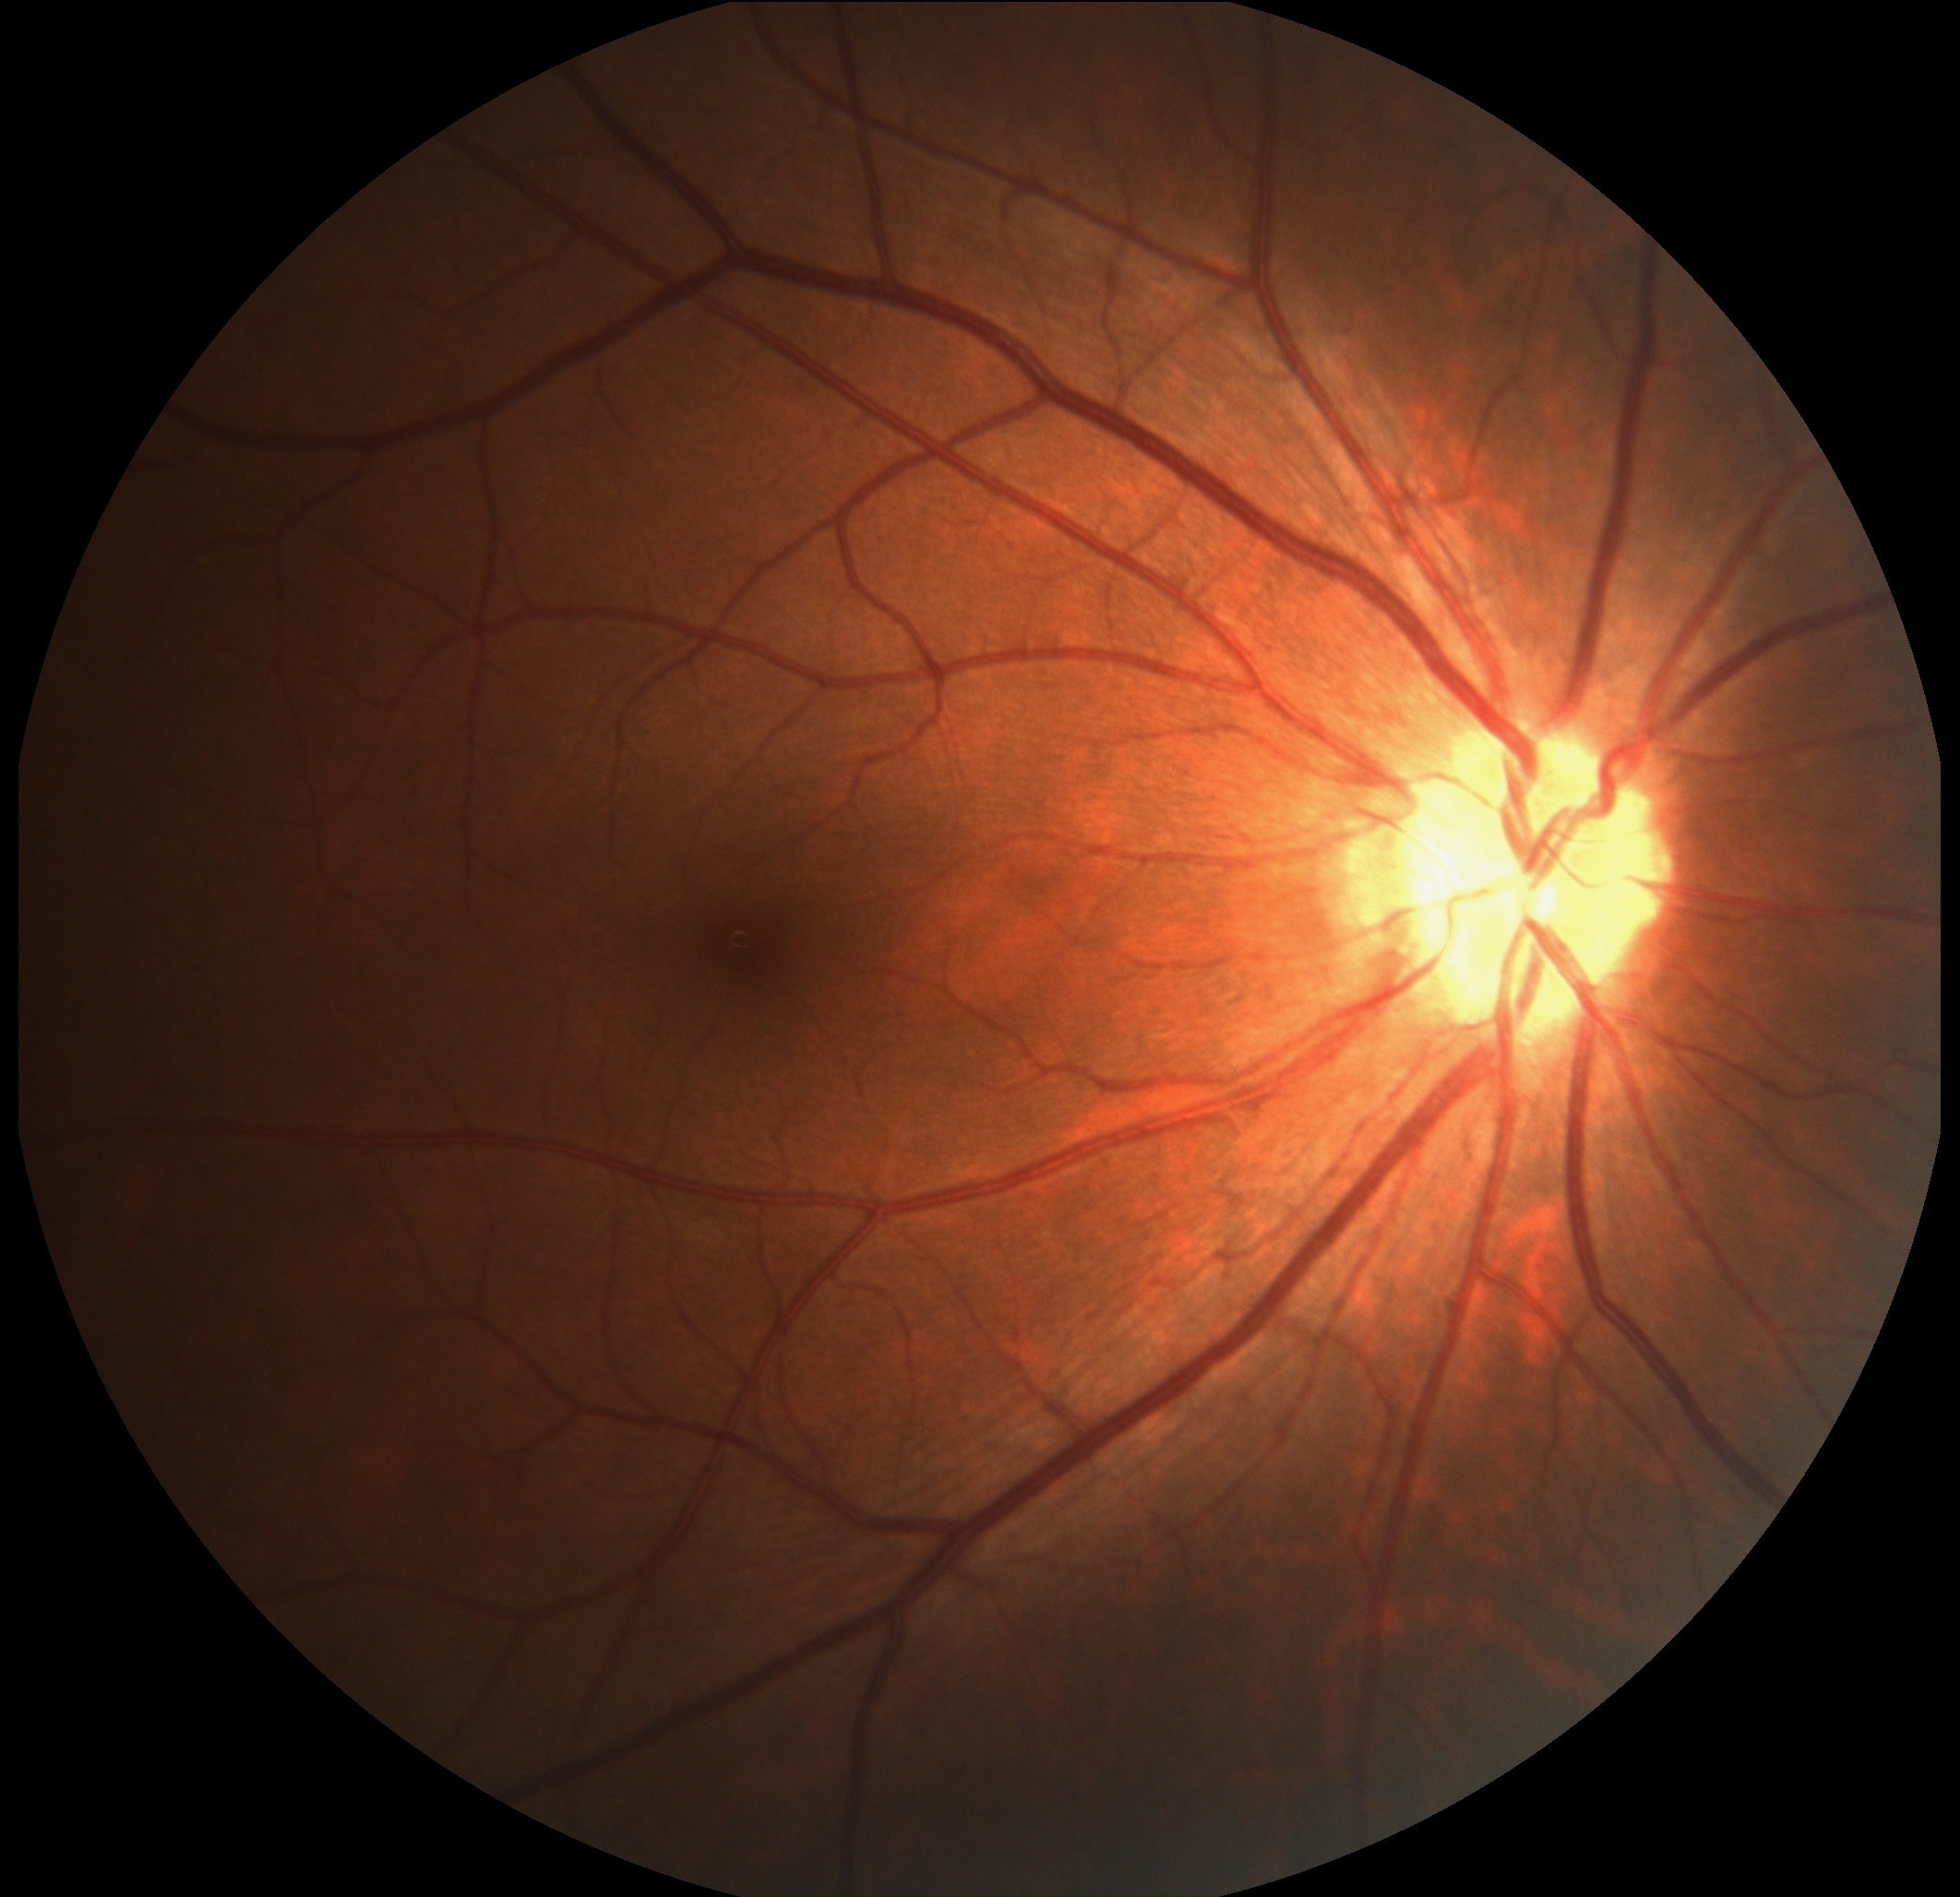

Diabetic retinopathy (DR) is grade 0.